FOV: 45 degrees — 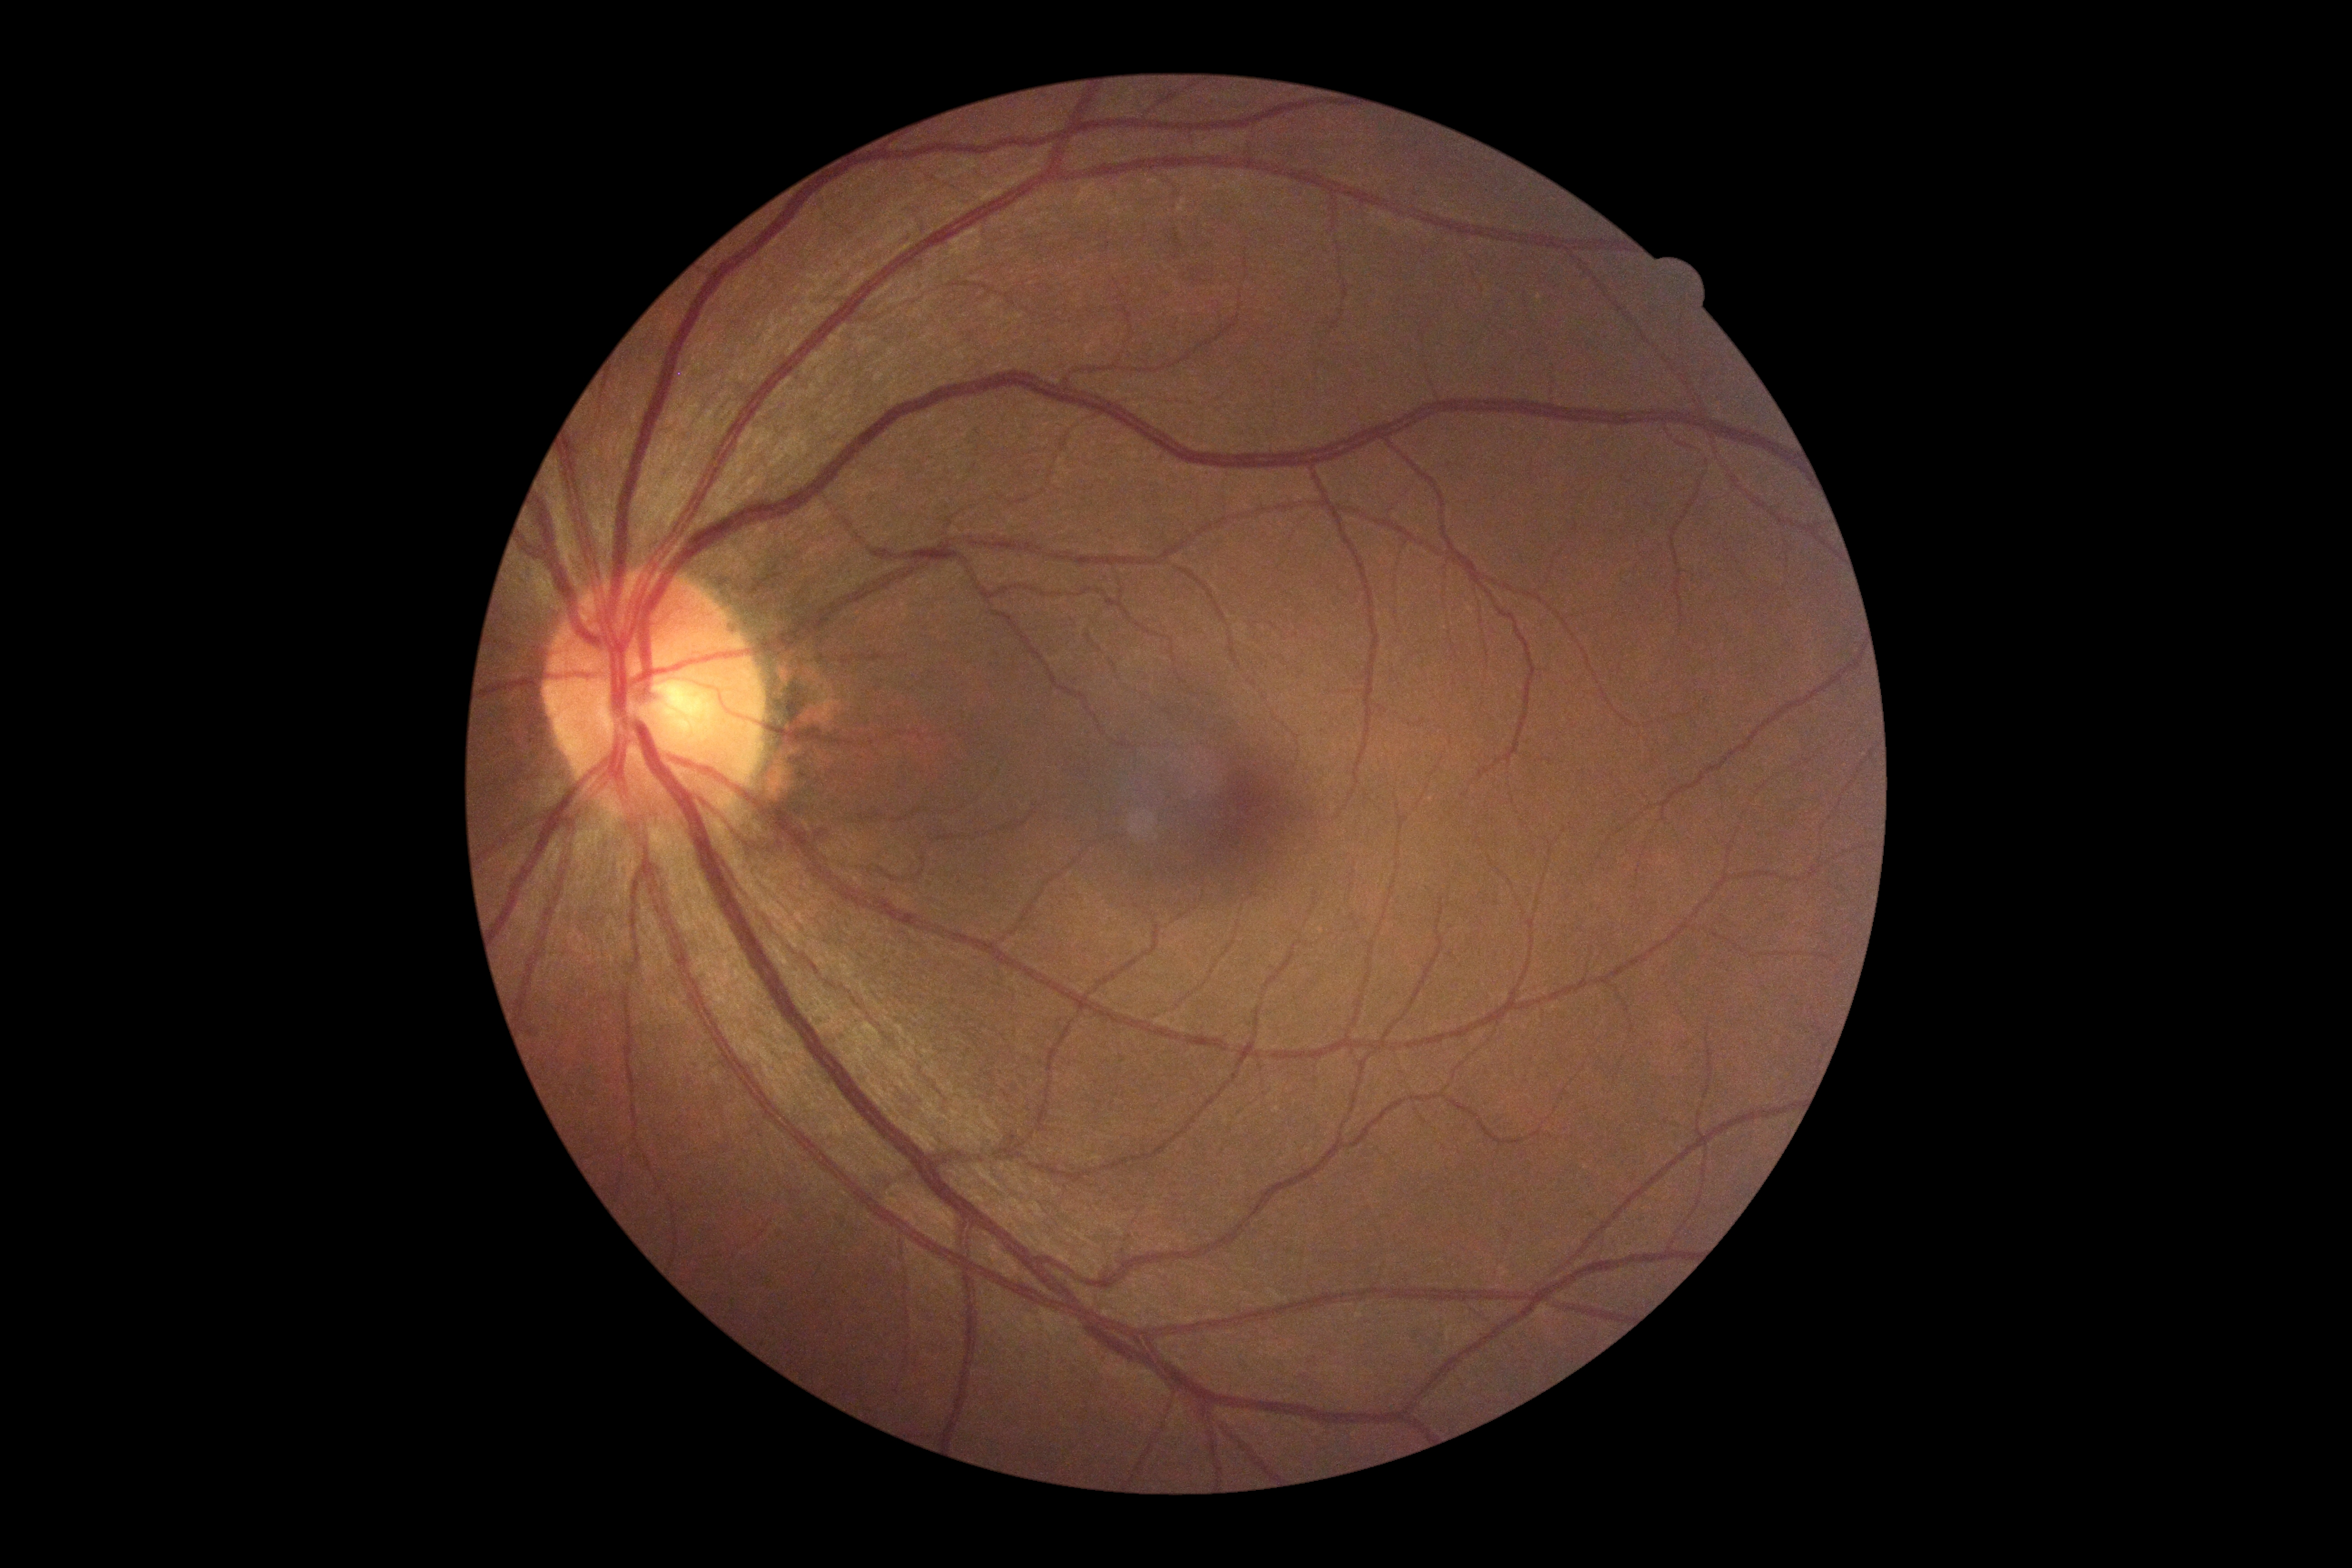

diabetic retinopathy severity@grade 0 (no apparent retinopathy) — no visible signs of diabetic retinopathy.